512 x 512 pixels
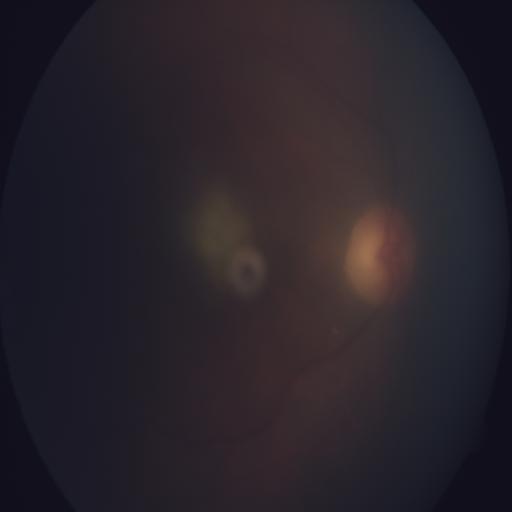 The image shows media haze.